1240x1240px; infant wide-field retinal image
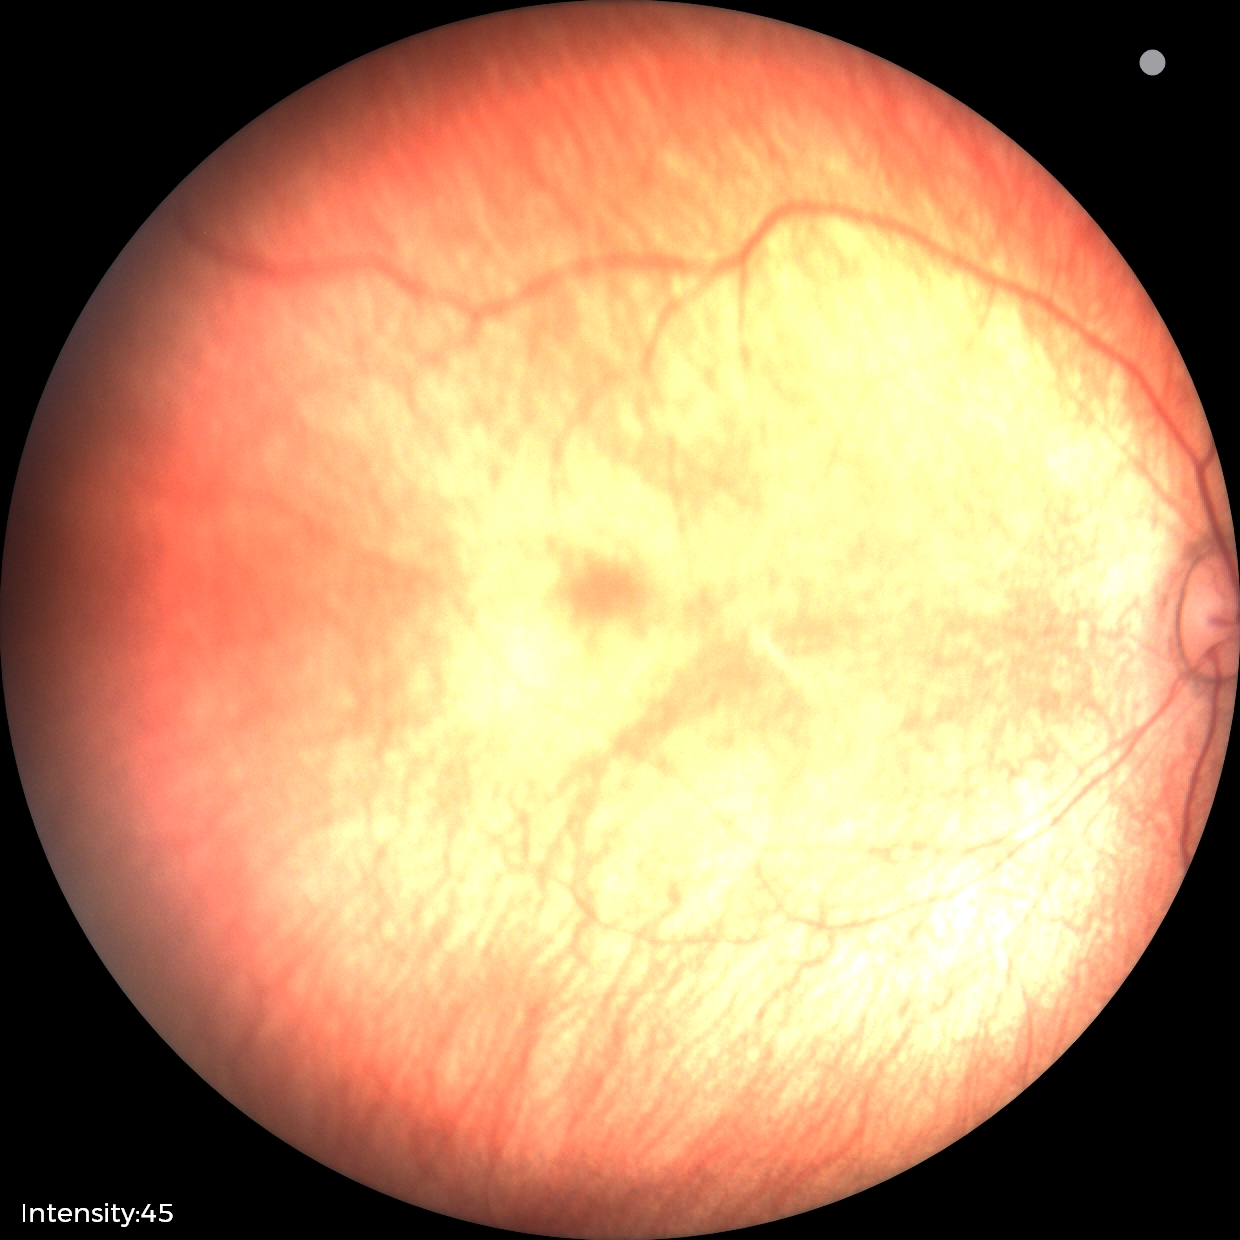

Assessment: physiological appearance.